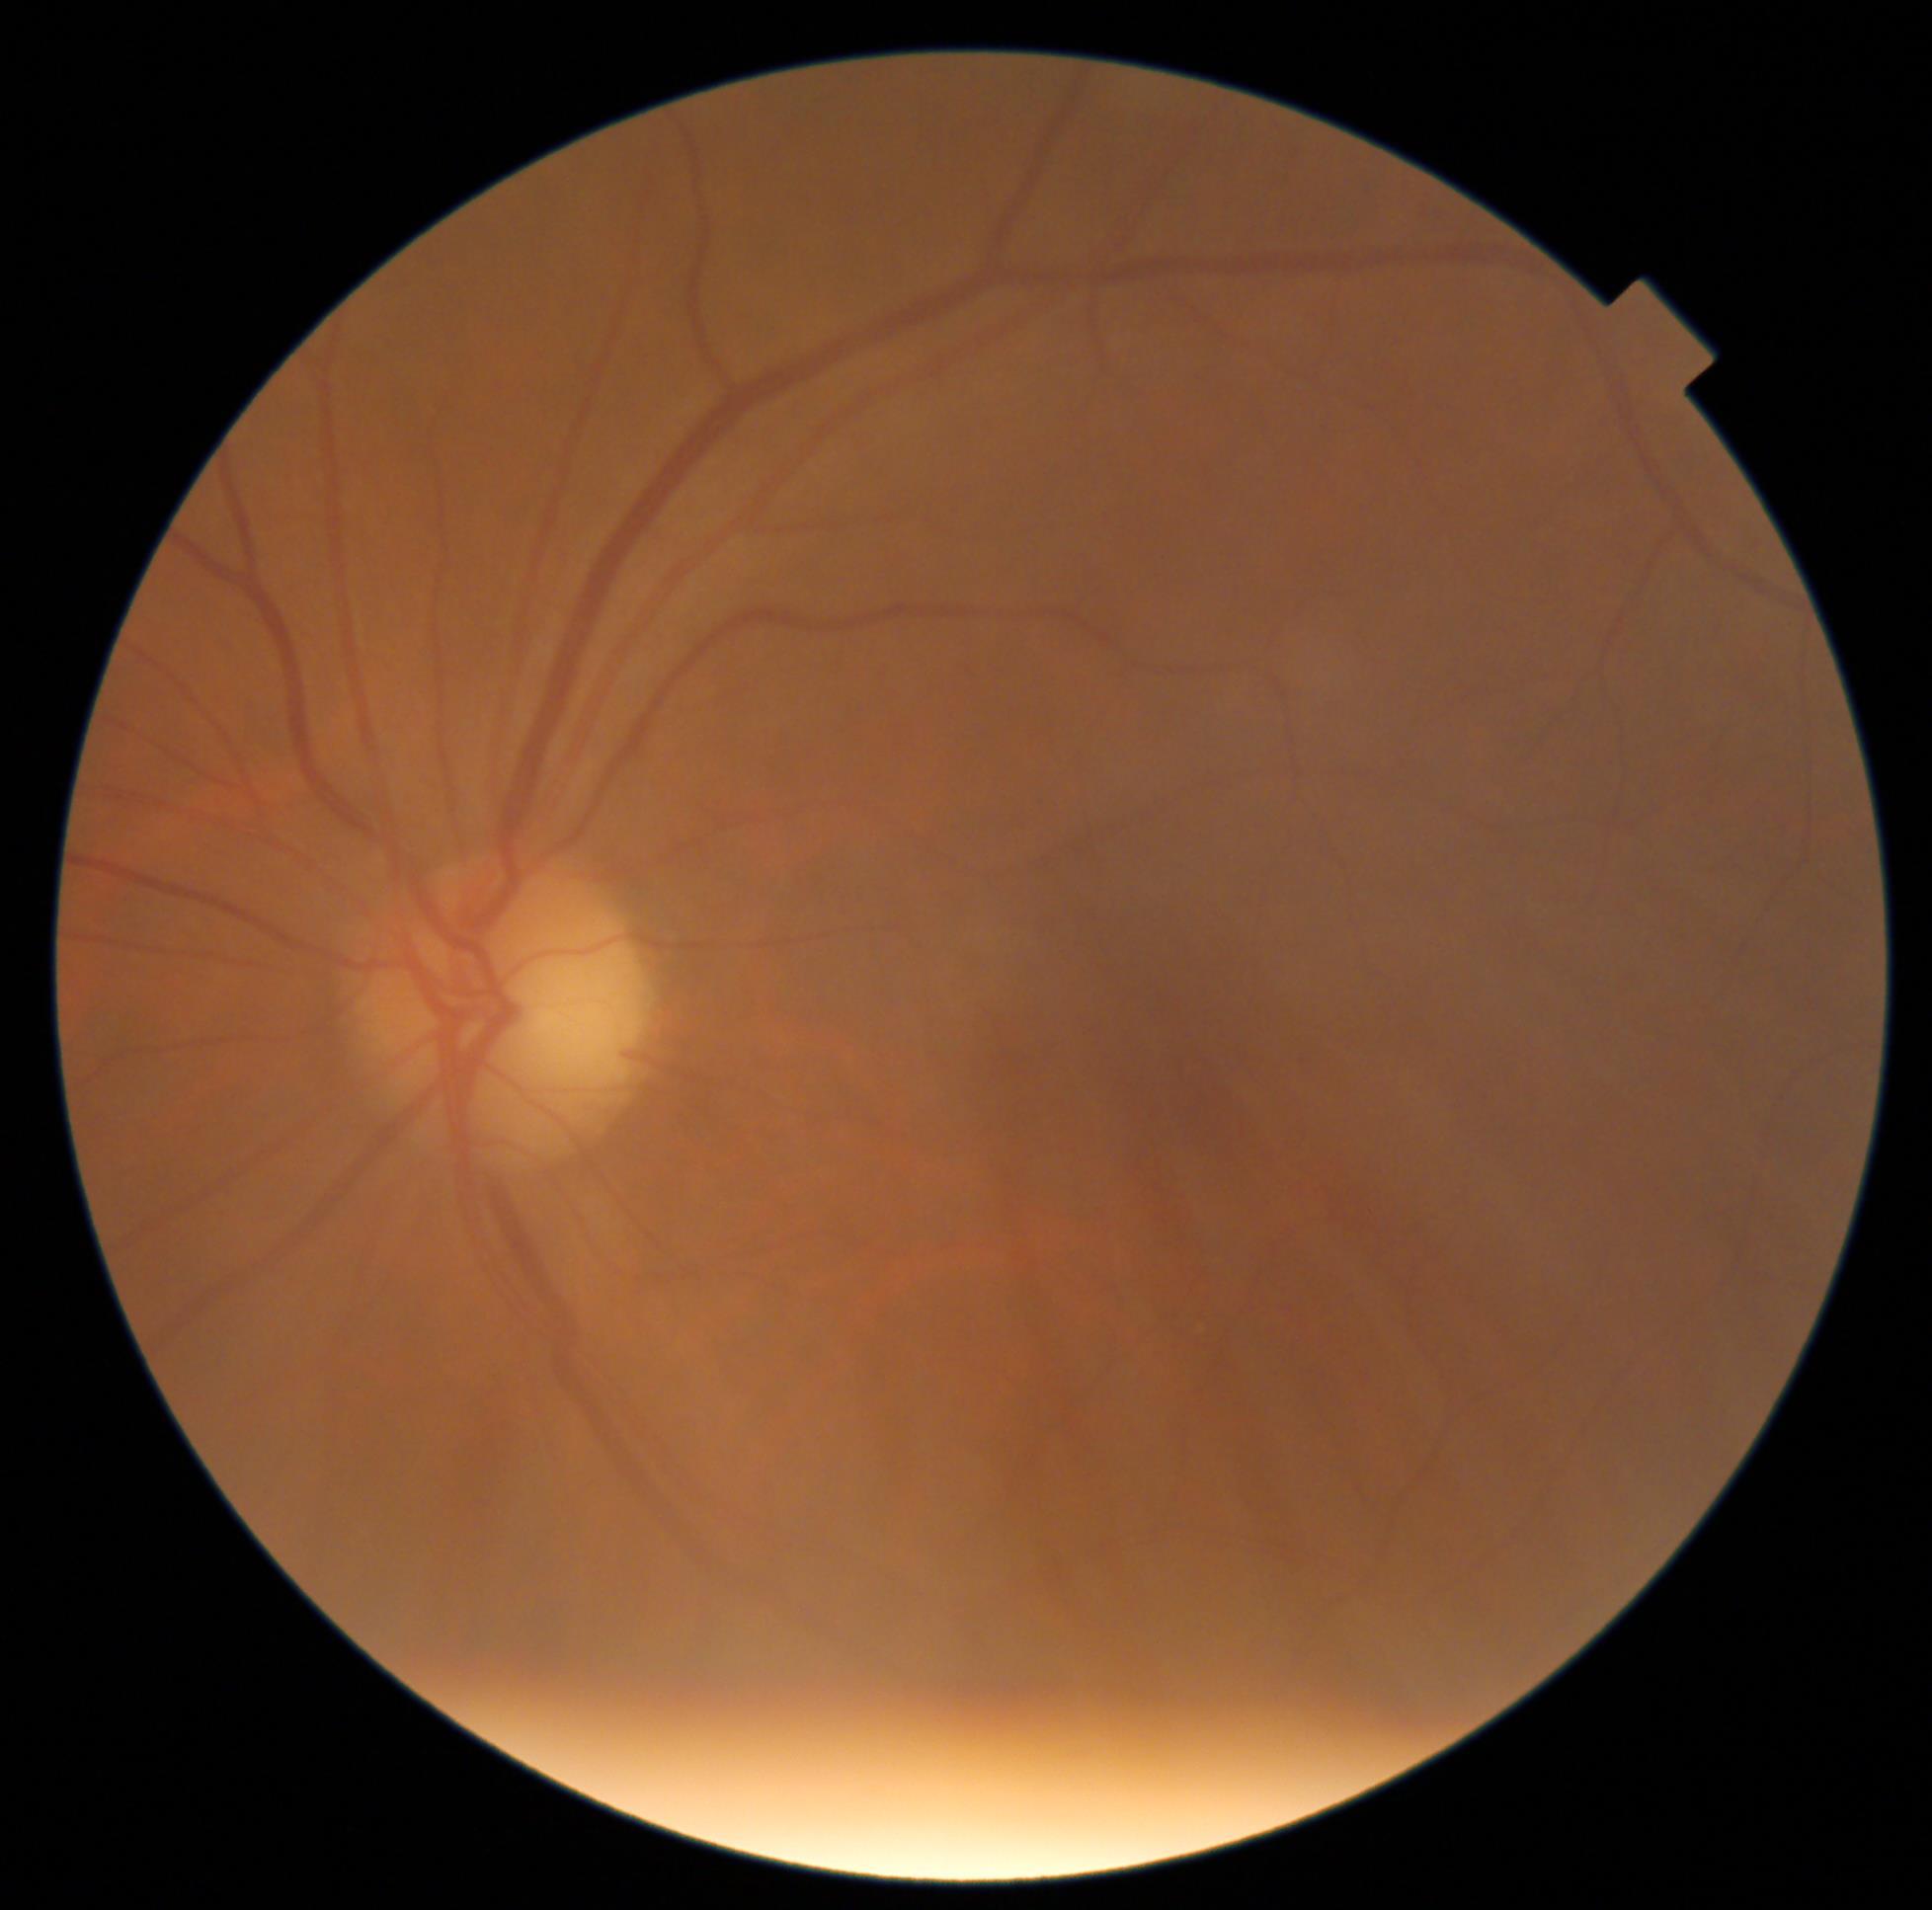 Diabetic retinopathy (DR) is 0/4.